Fundus photo:
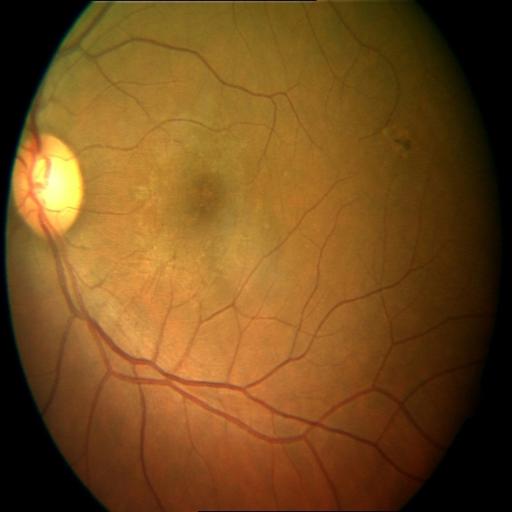 Pathology: MS (macular scar).